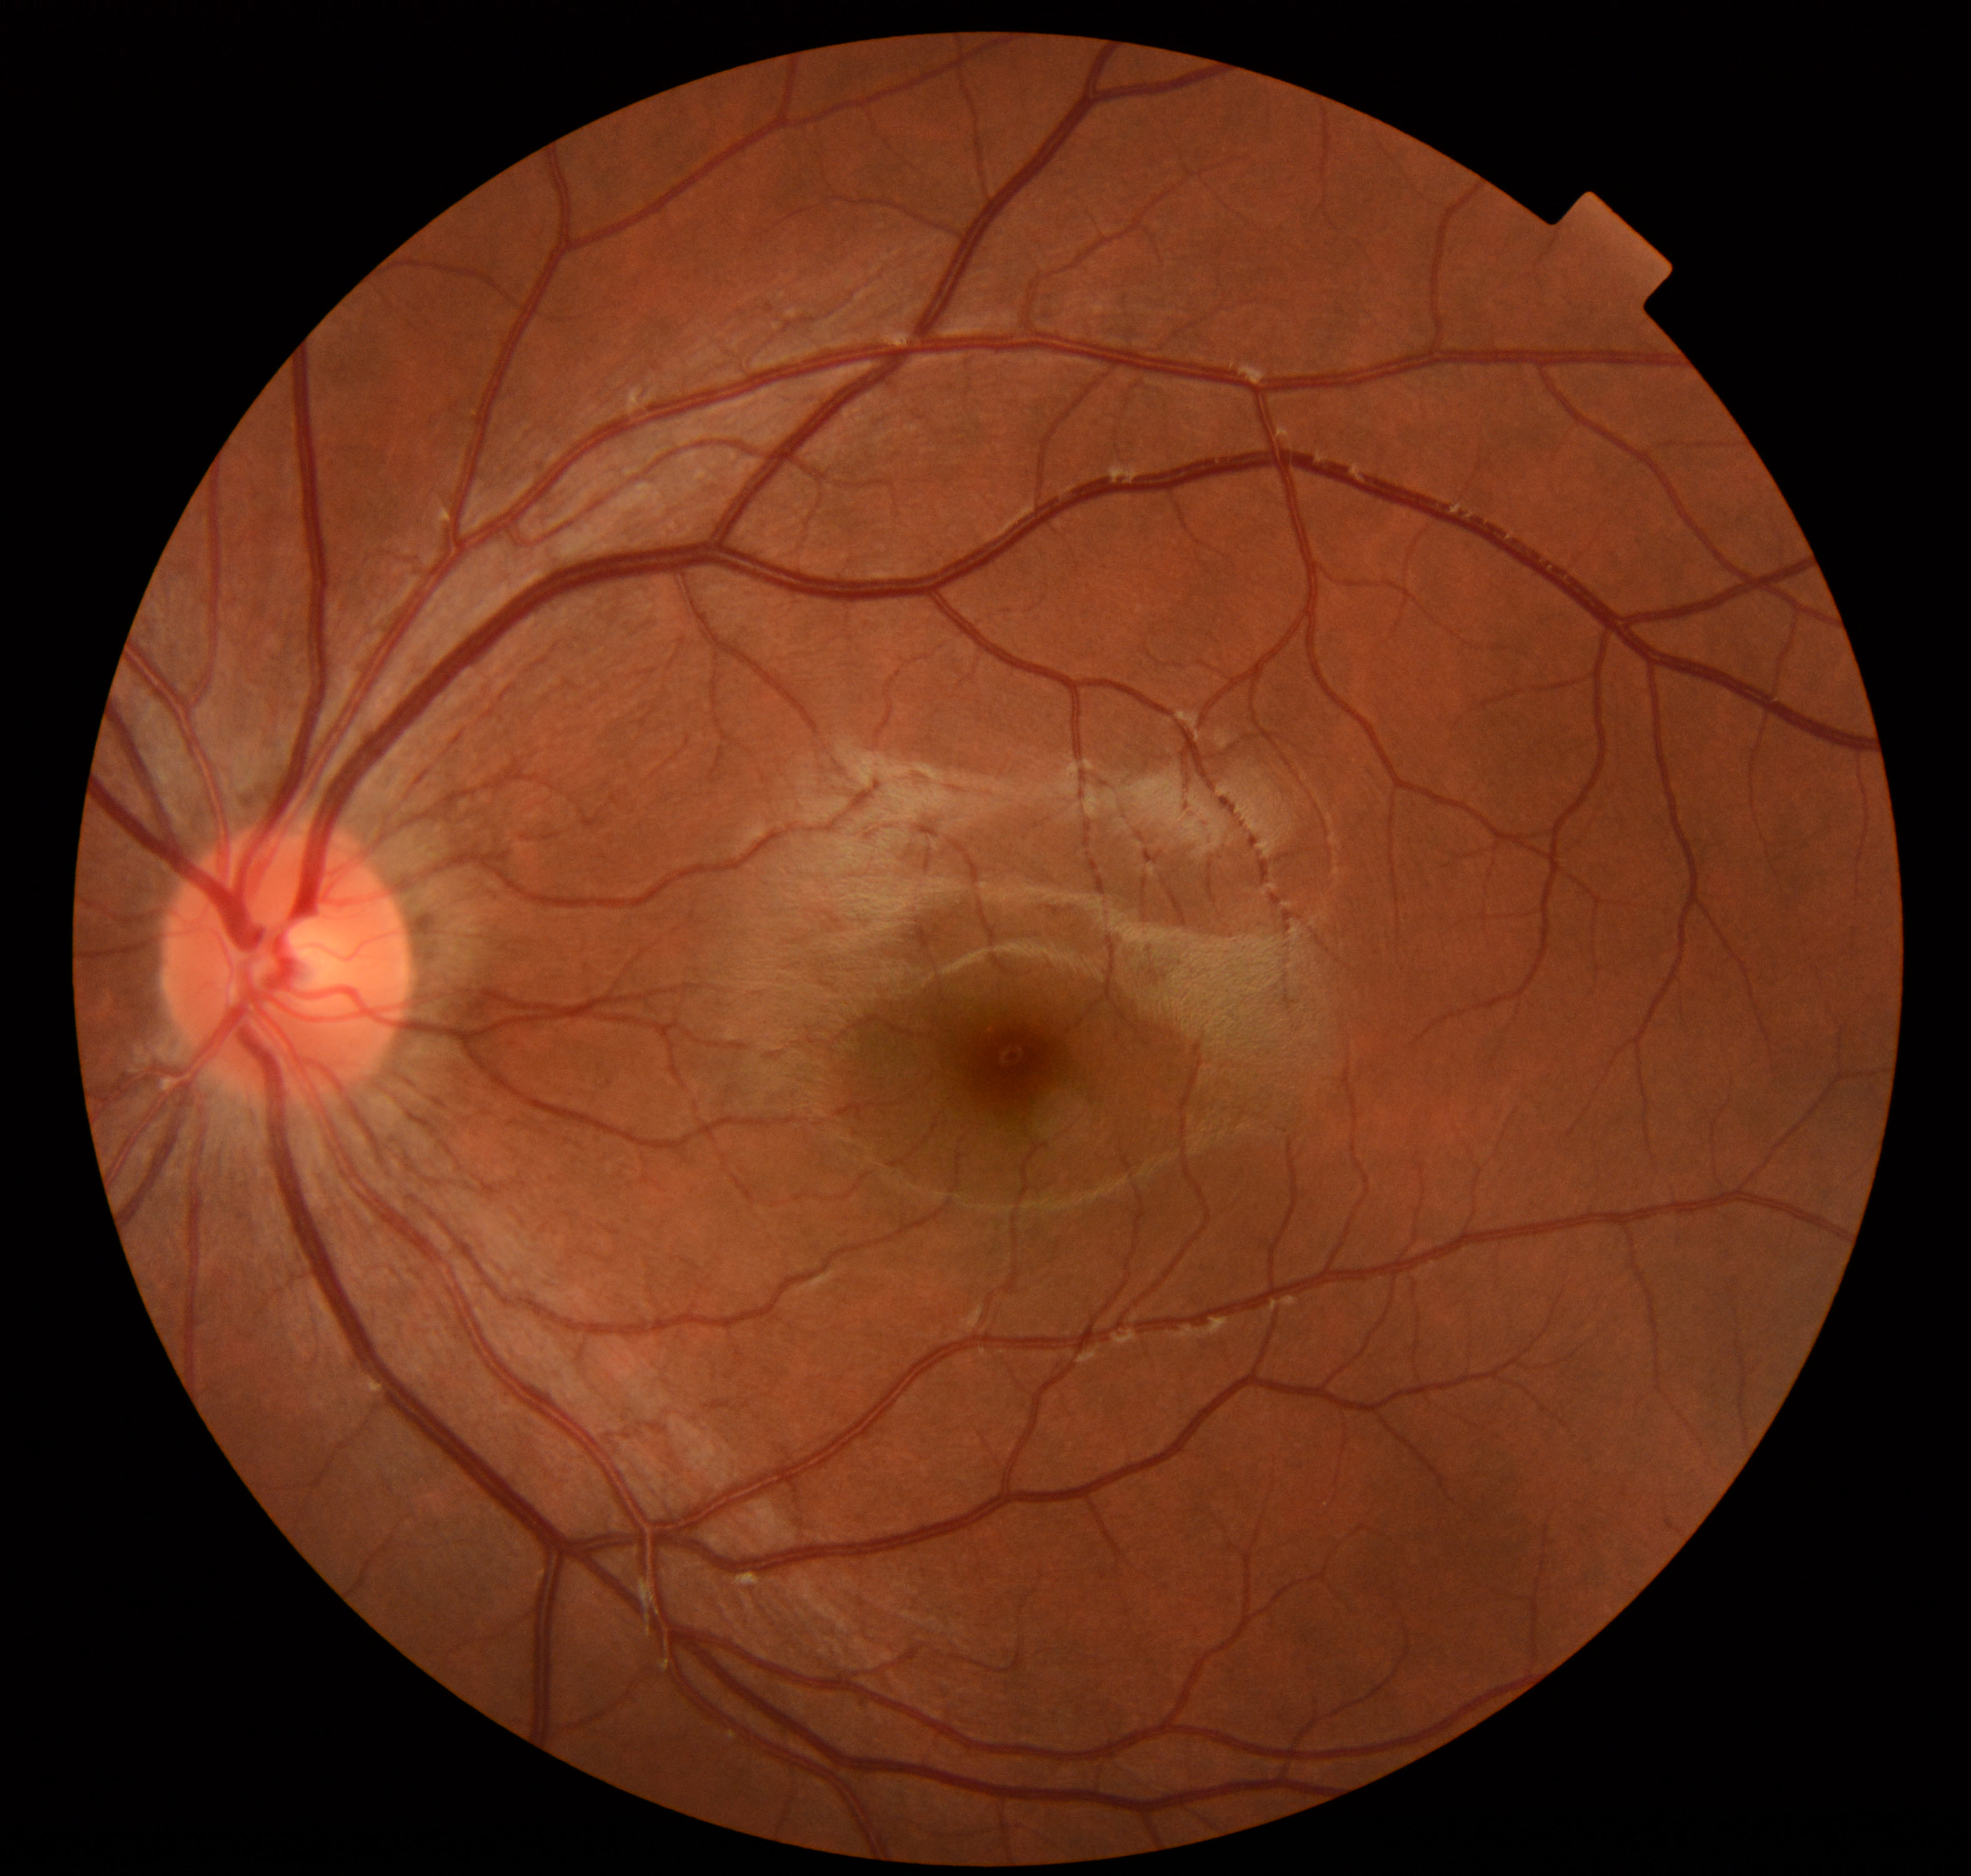 Impression: within normal limits.